50-degree field of view · posterior pole field covering the optic disc and macula · camera: Topcon TRC-50DX — 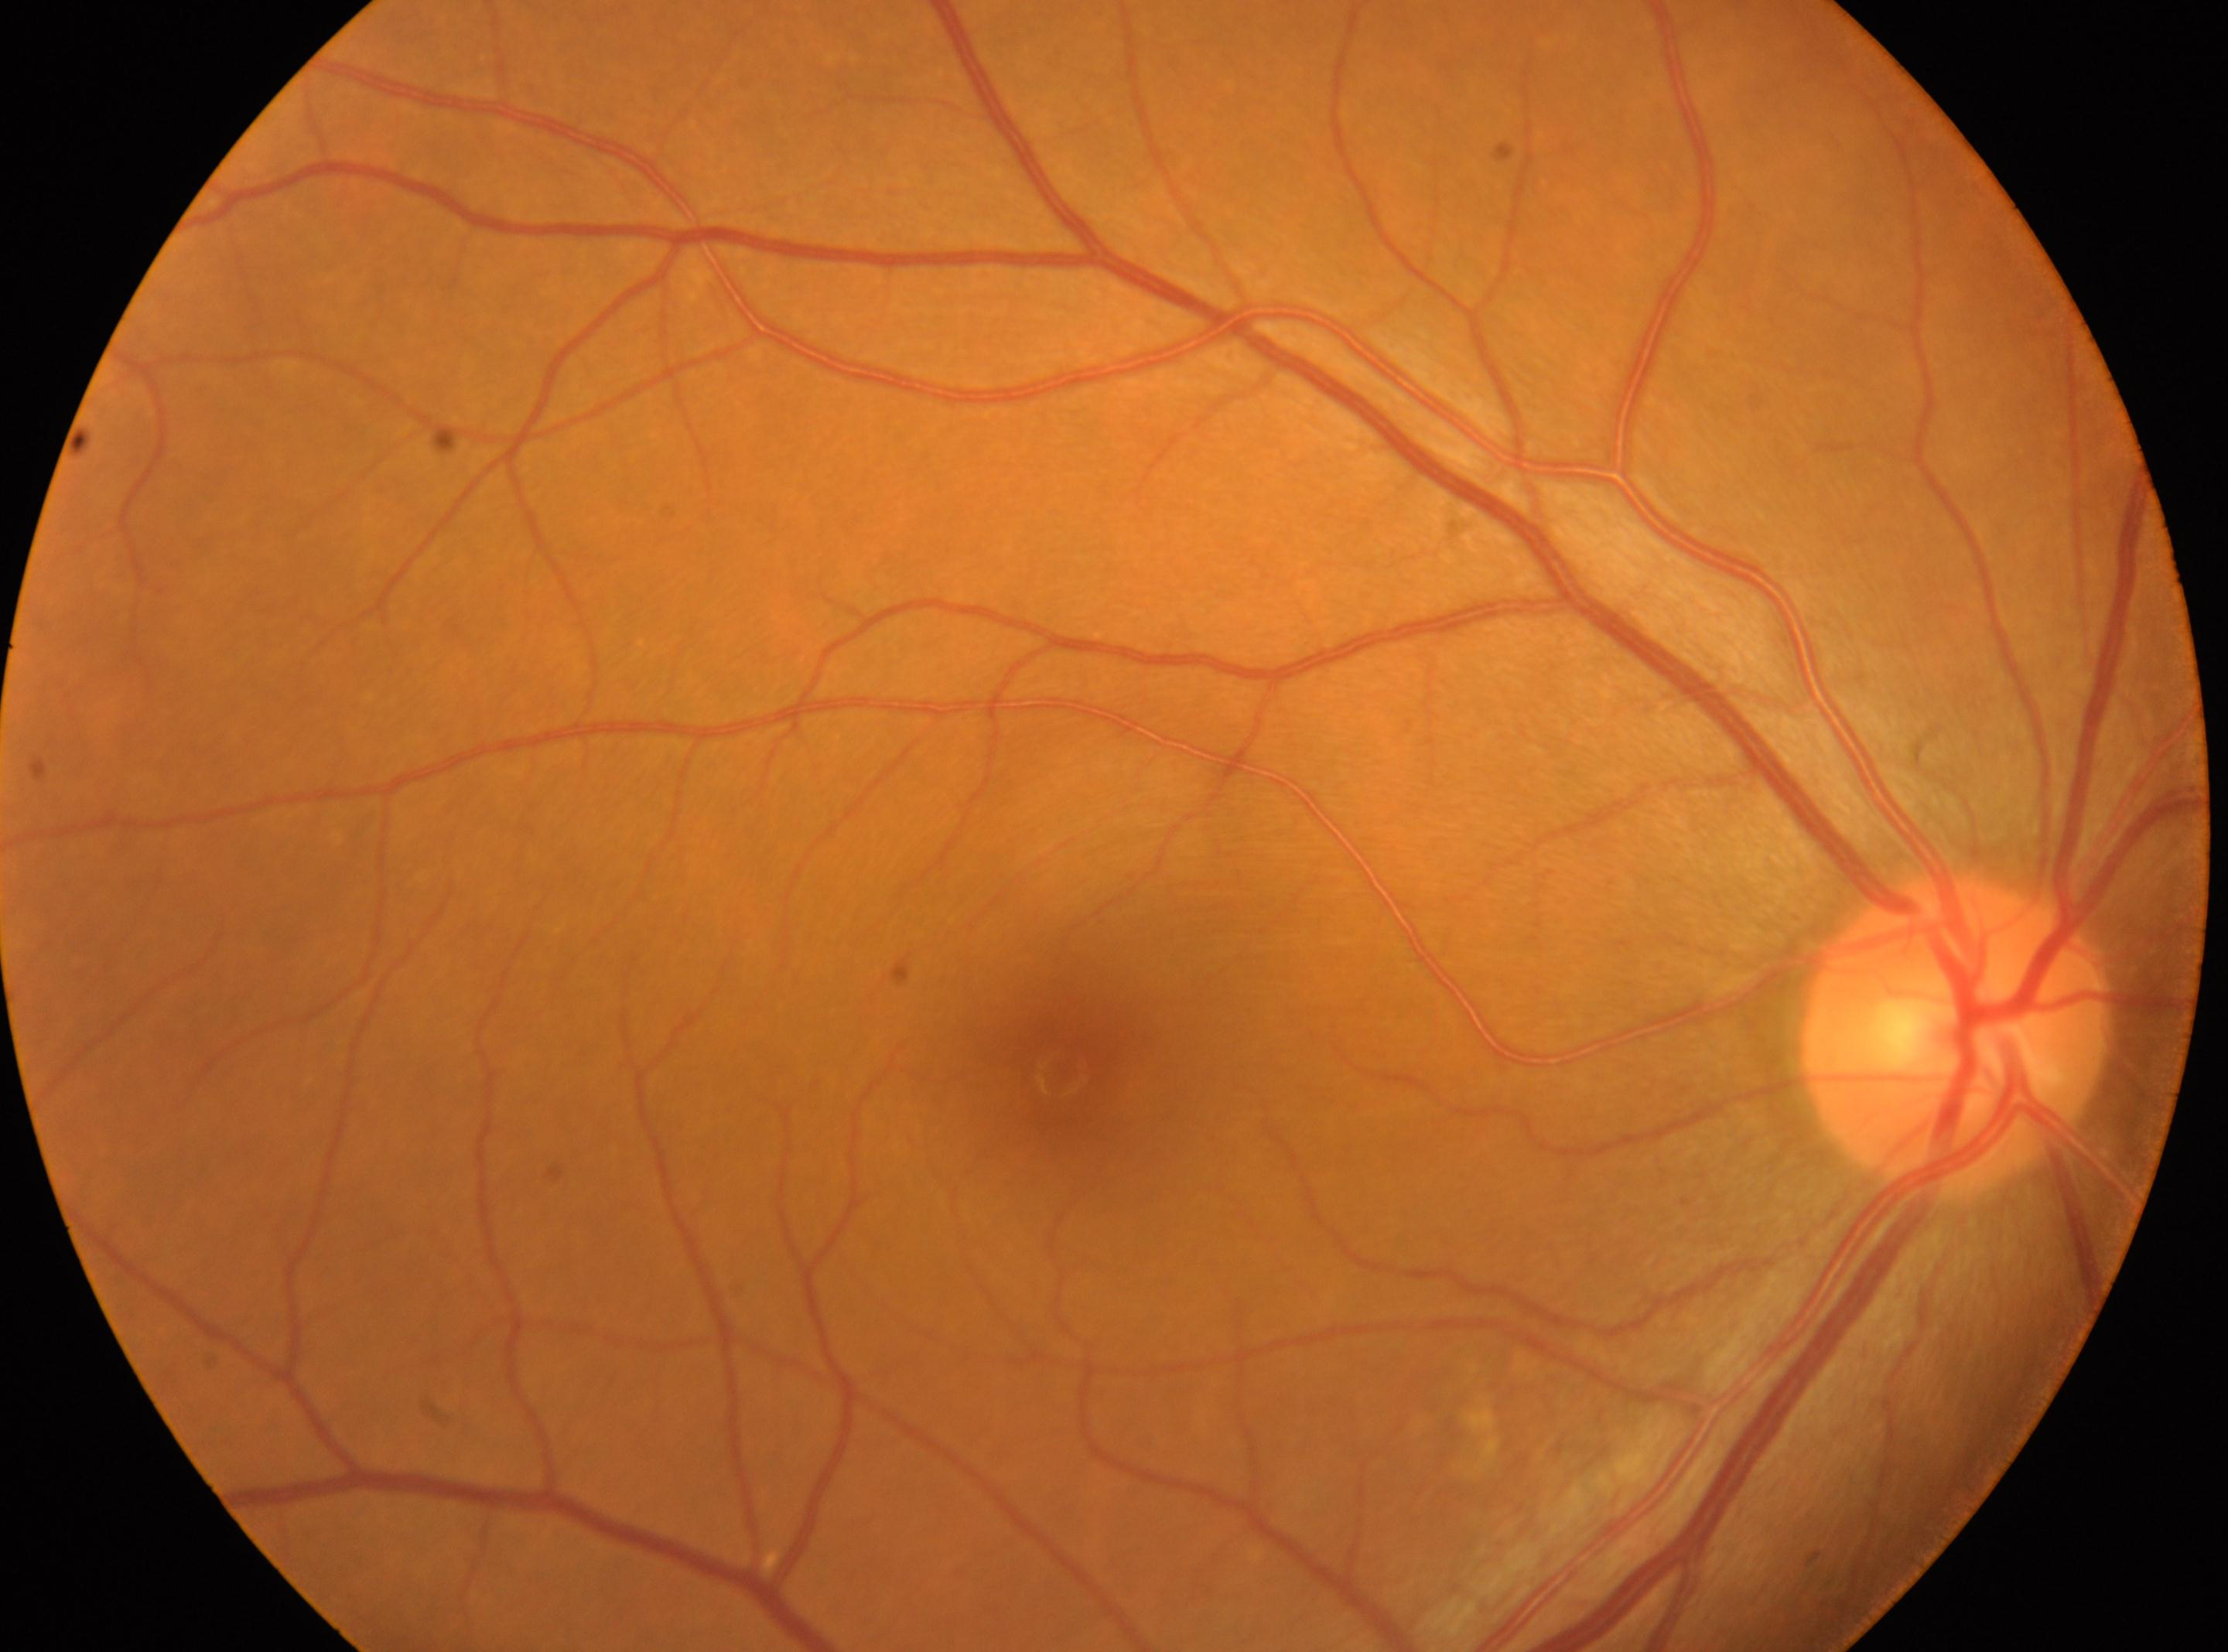
Macular center located at [1061, 1073]. DR grade: 0 (no apparent retinopathy). No diabetic retinal disease findings. The image shows the oculus dexter. Optic nerve head located at [1954, 1035].